Image size 2212x1659, 45-degree field of view:
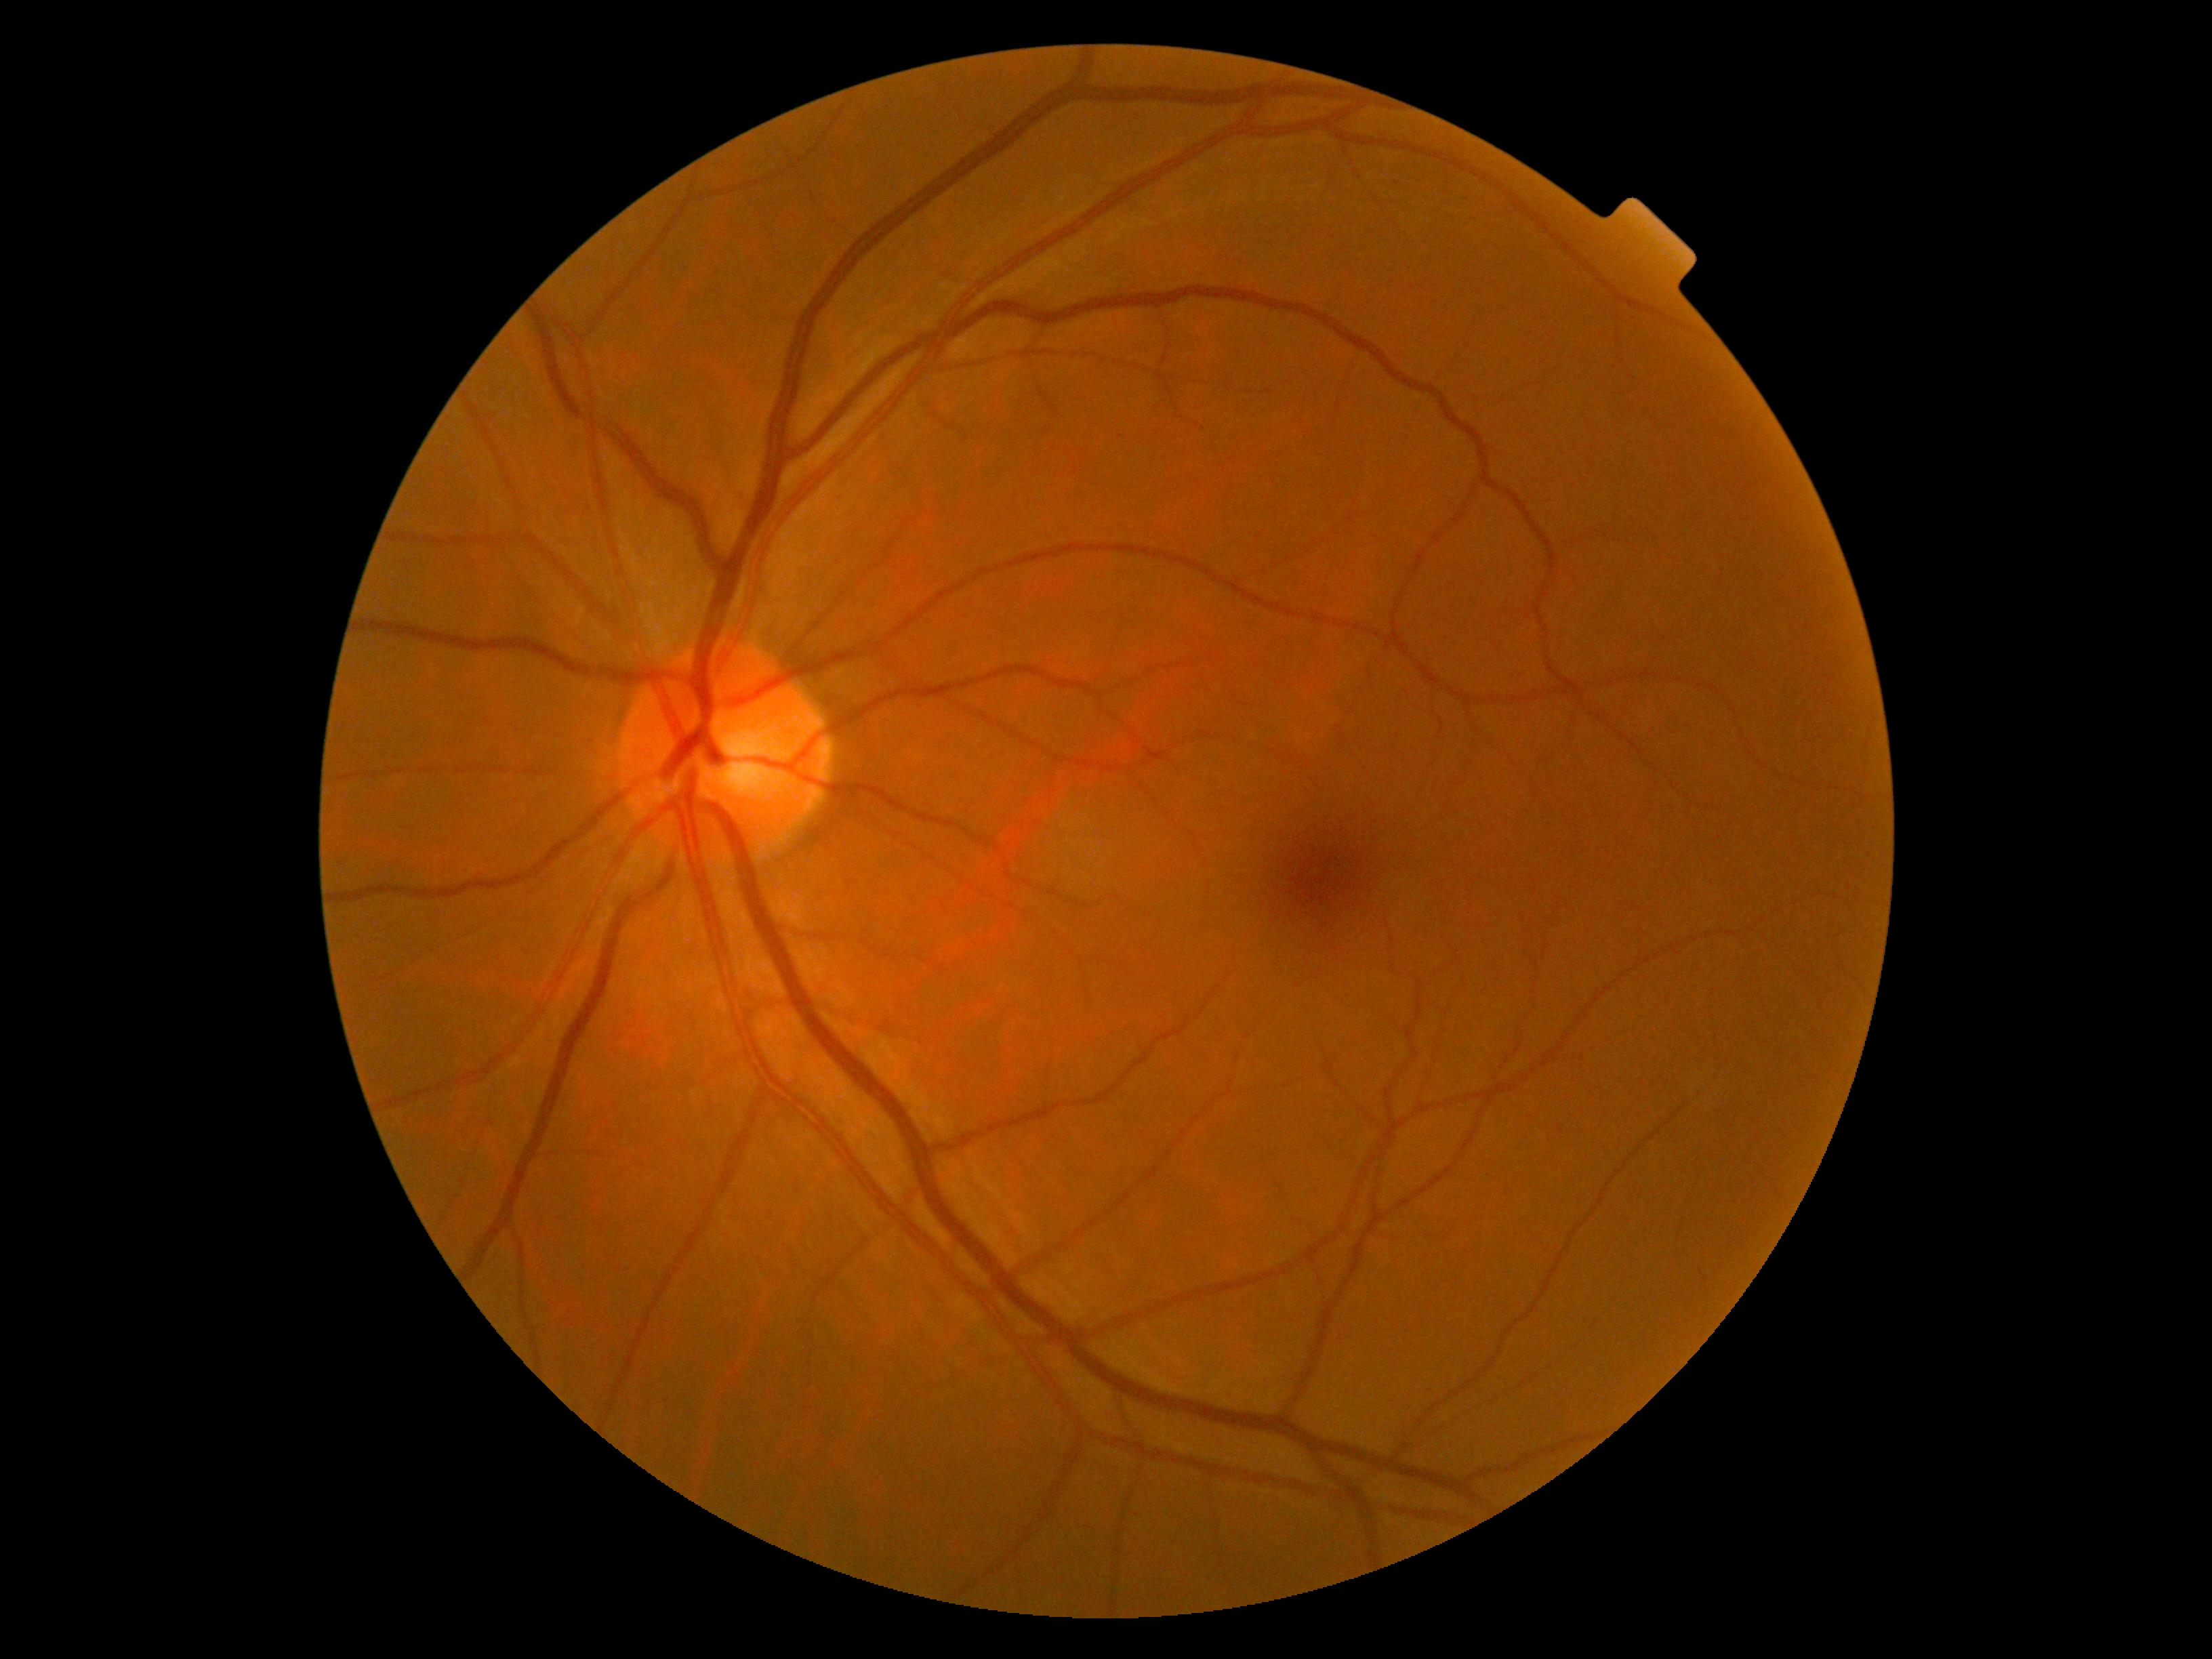 No diabetic retinal disease findings. Retinopathy: 0/4.